Captured with the Phoenix ICON (100° field of view); wide-field fundus image from infant ROP screening; 1240 x 1240 pixels — 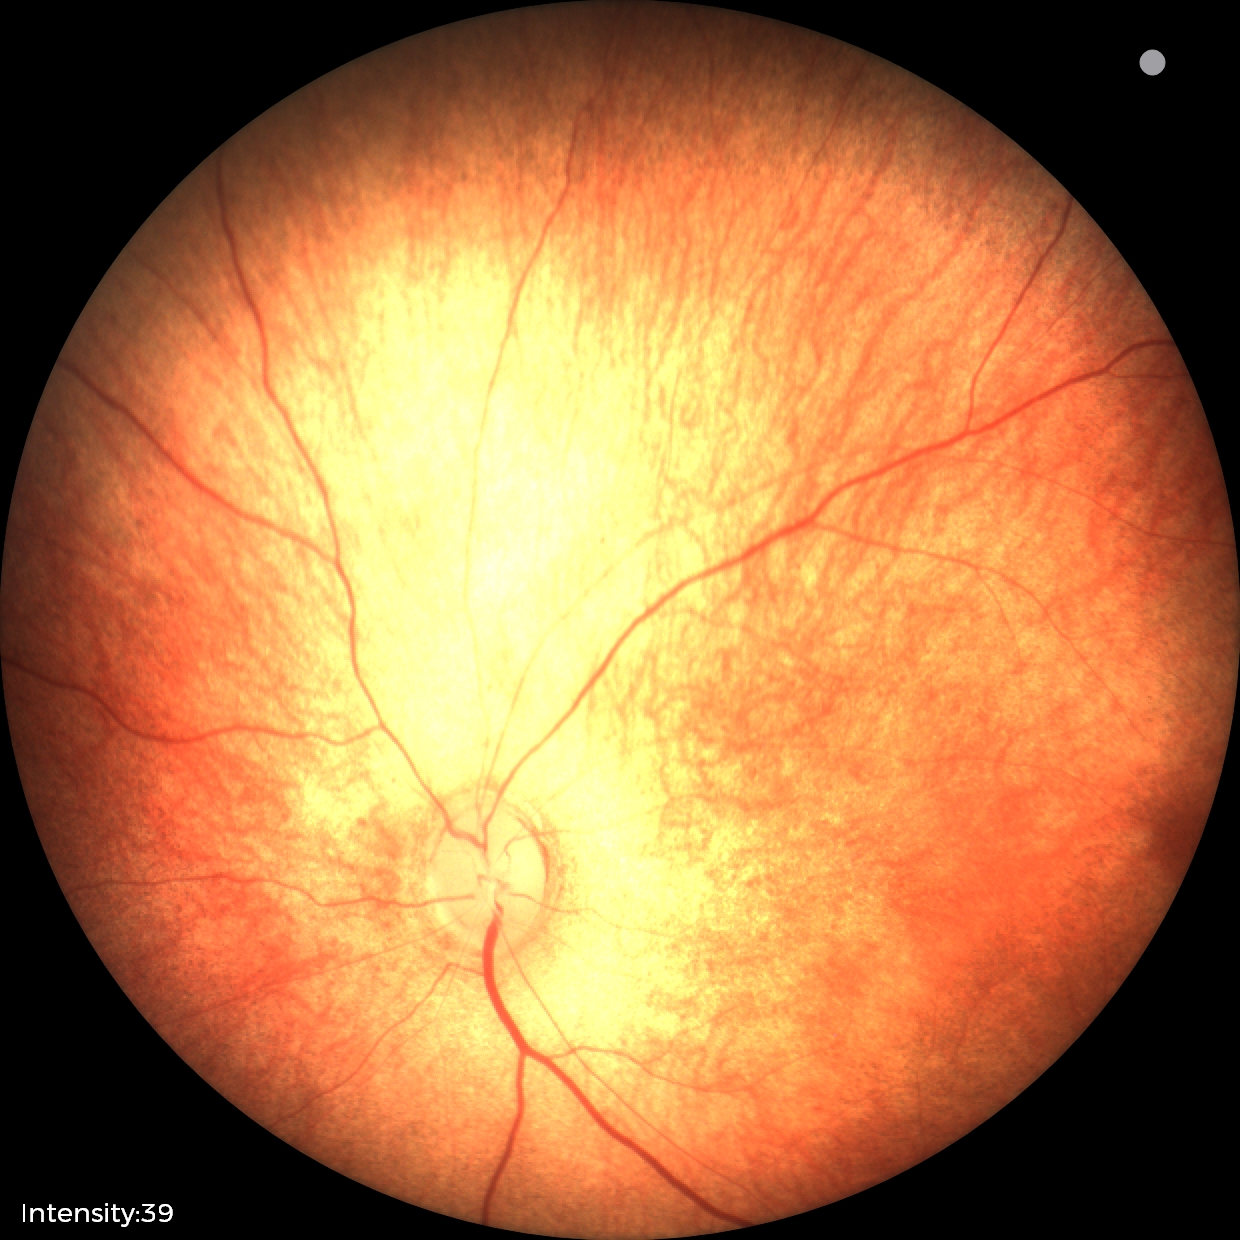 Impression = physiological appearance.